2048x1536px · retinal fundus photograph:
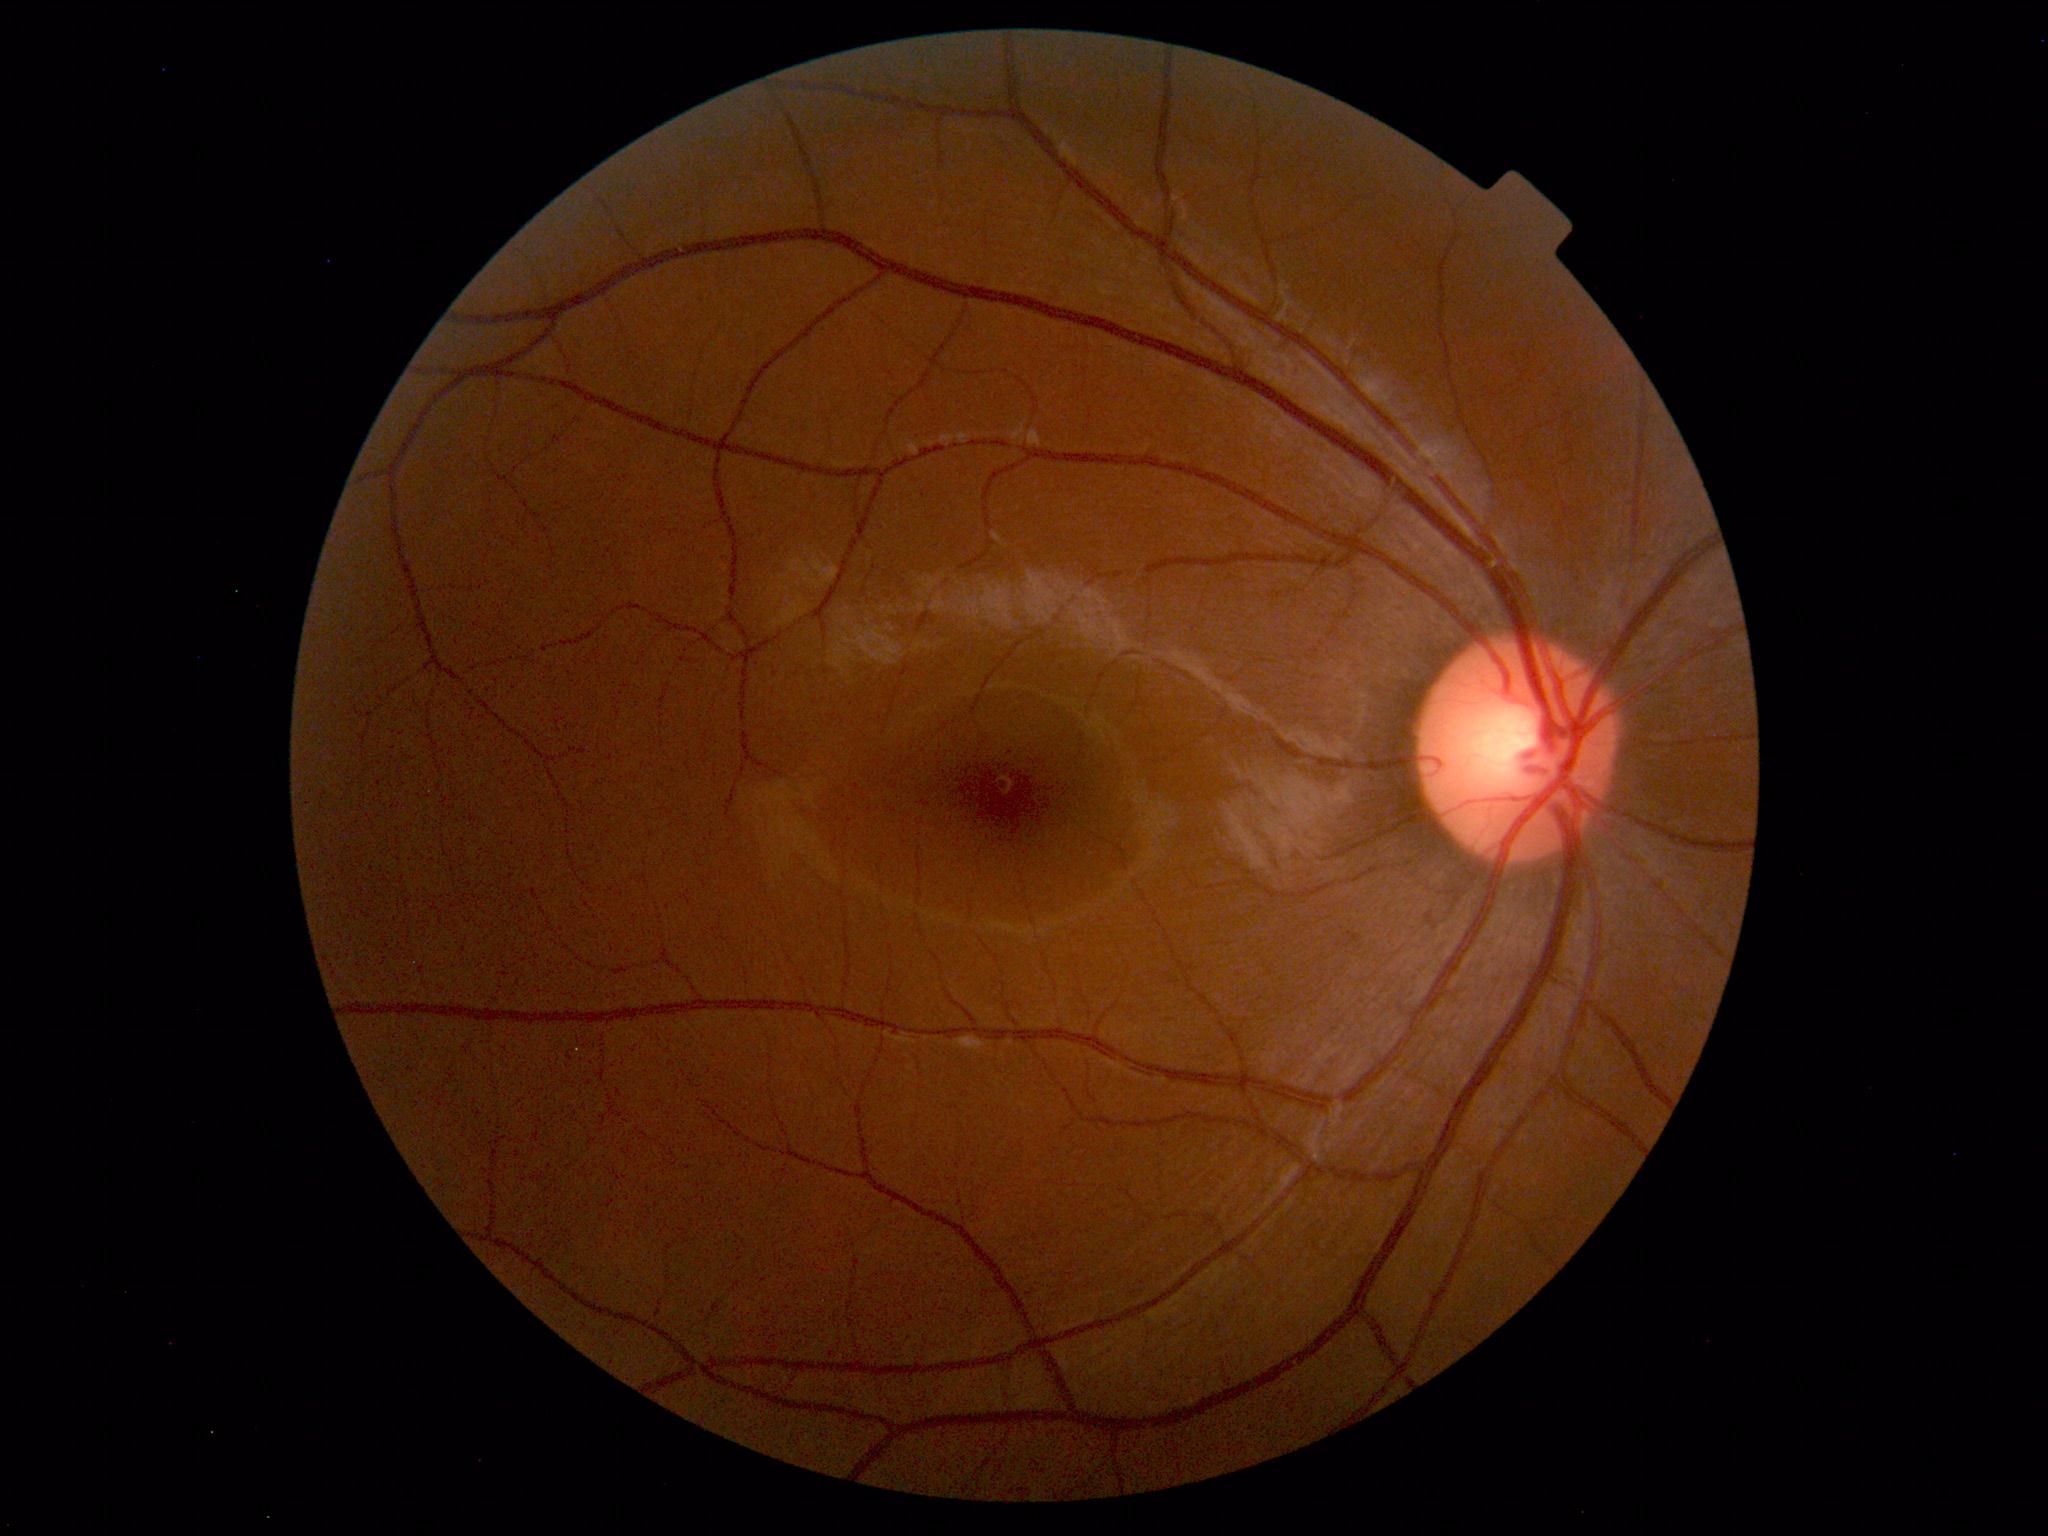 Within normal limits. No abnormalities identified.